Image size 2048x1536:
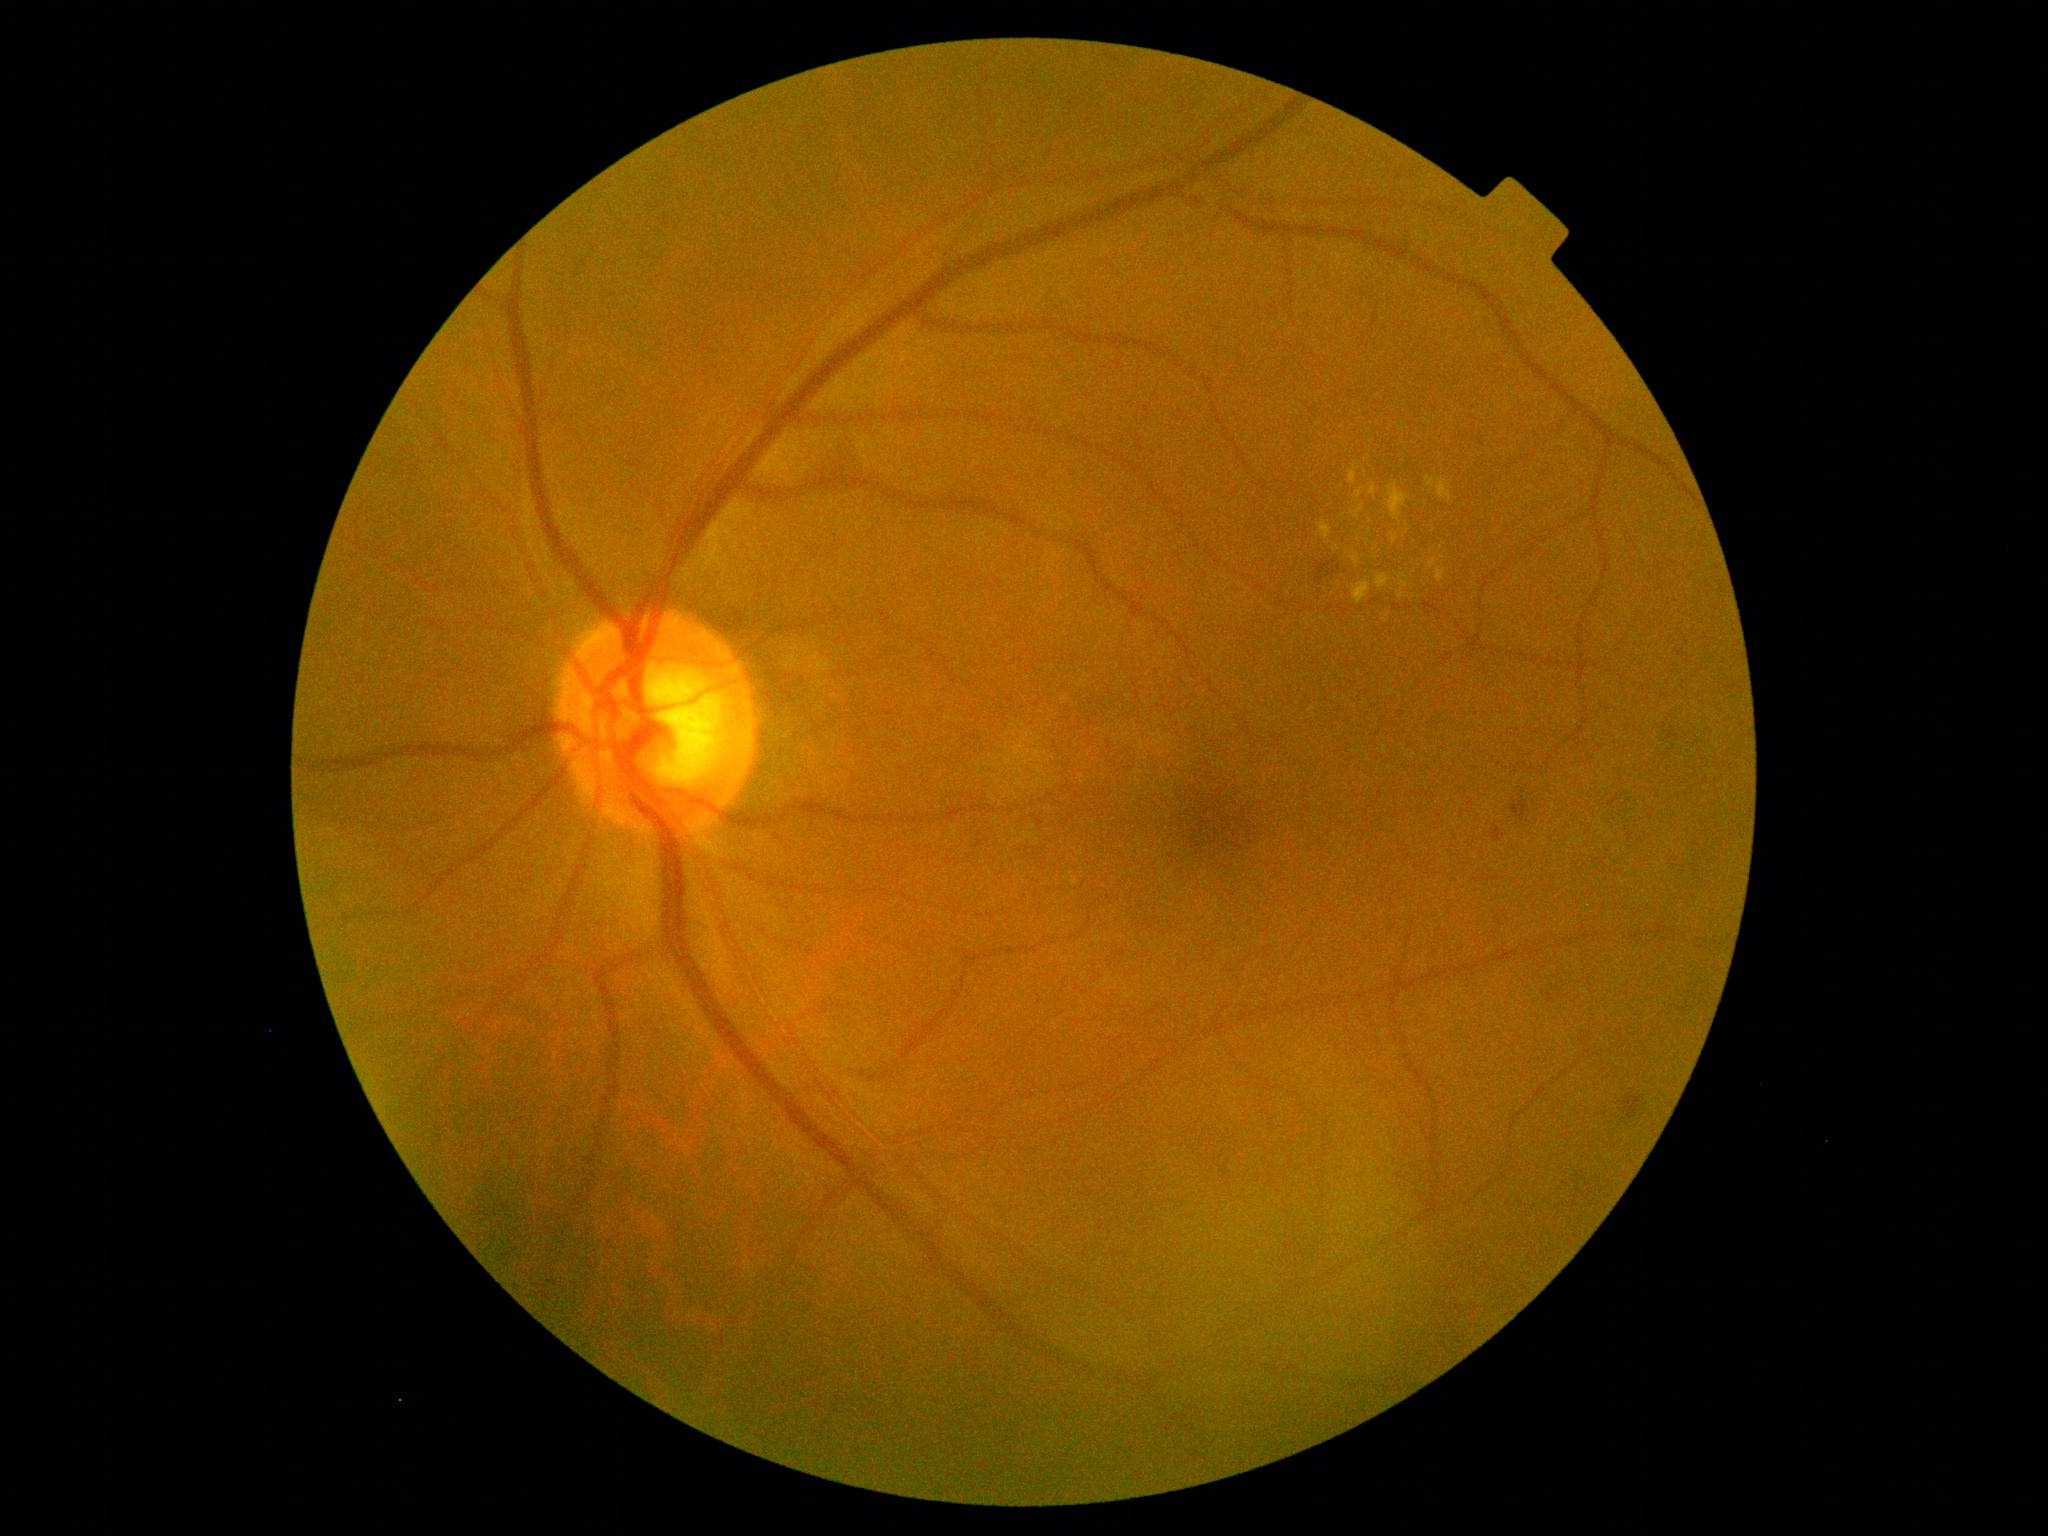

diabetic retinopathy grade@2.